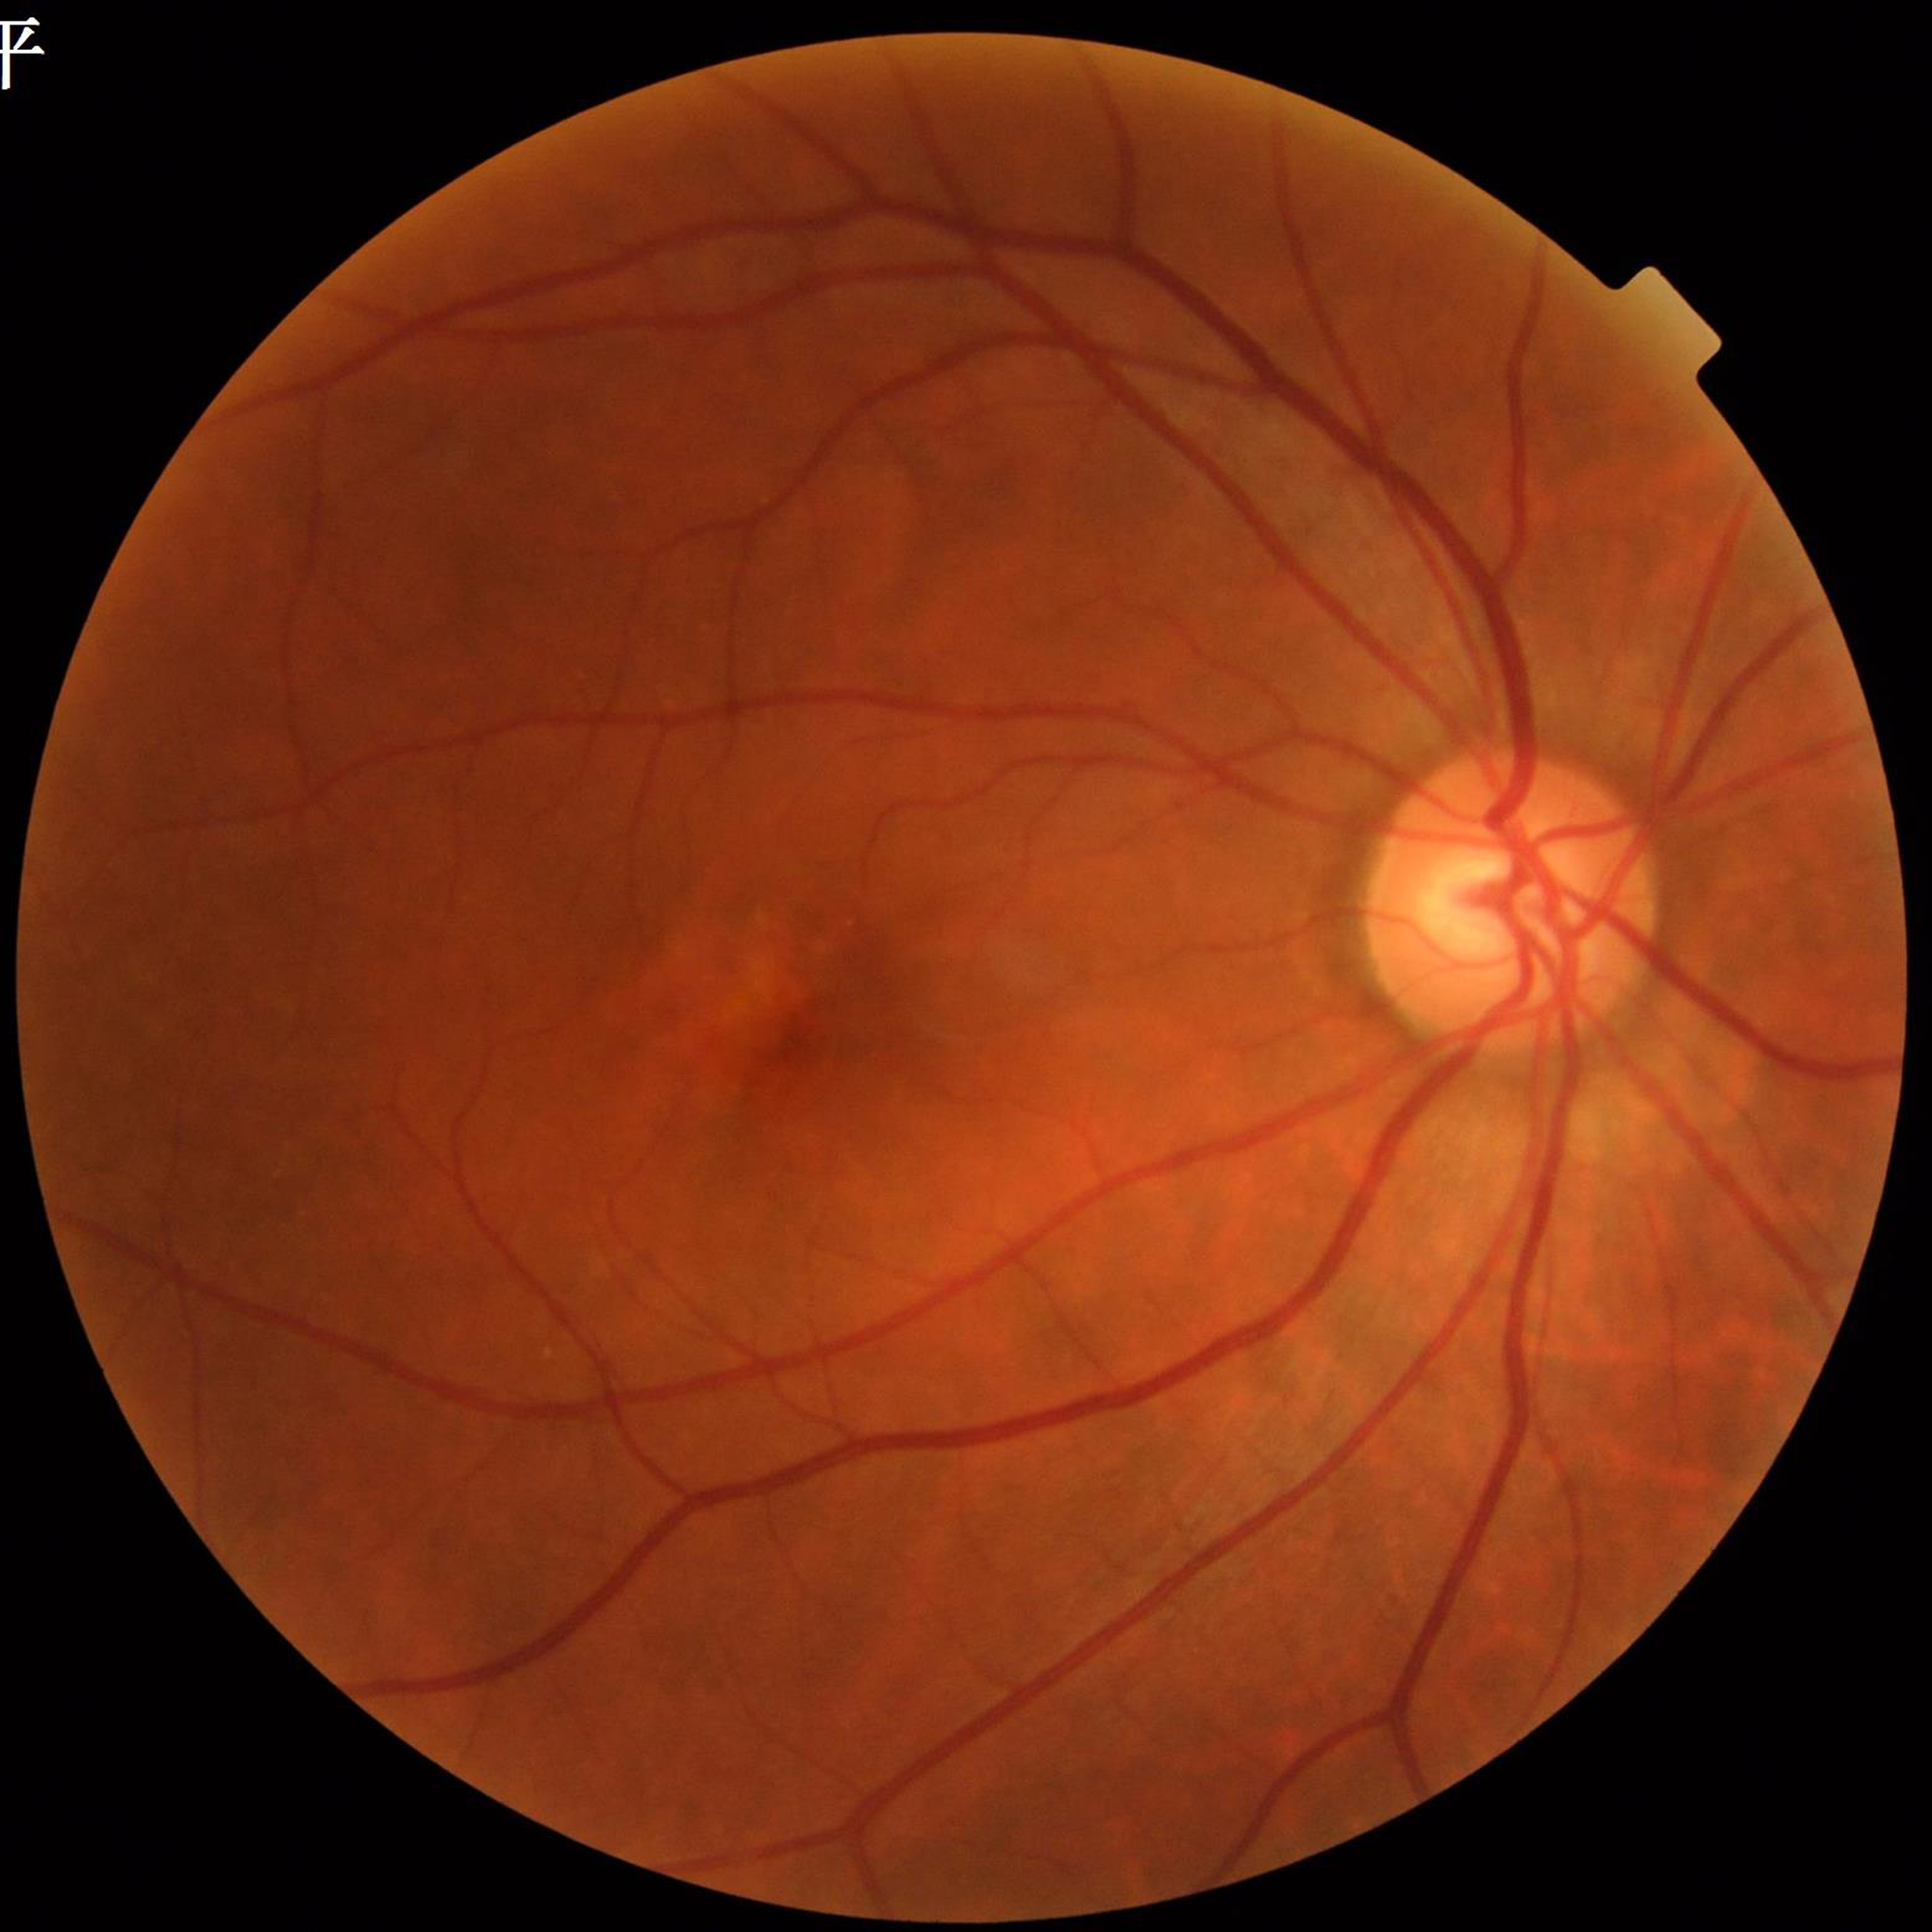
Diagnosed with AMD. Image quality: contrast adequate, no blur, illumination and color satisfactory.